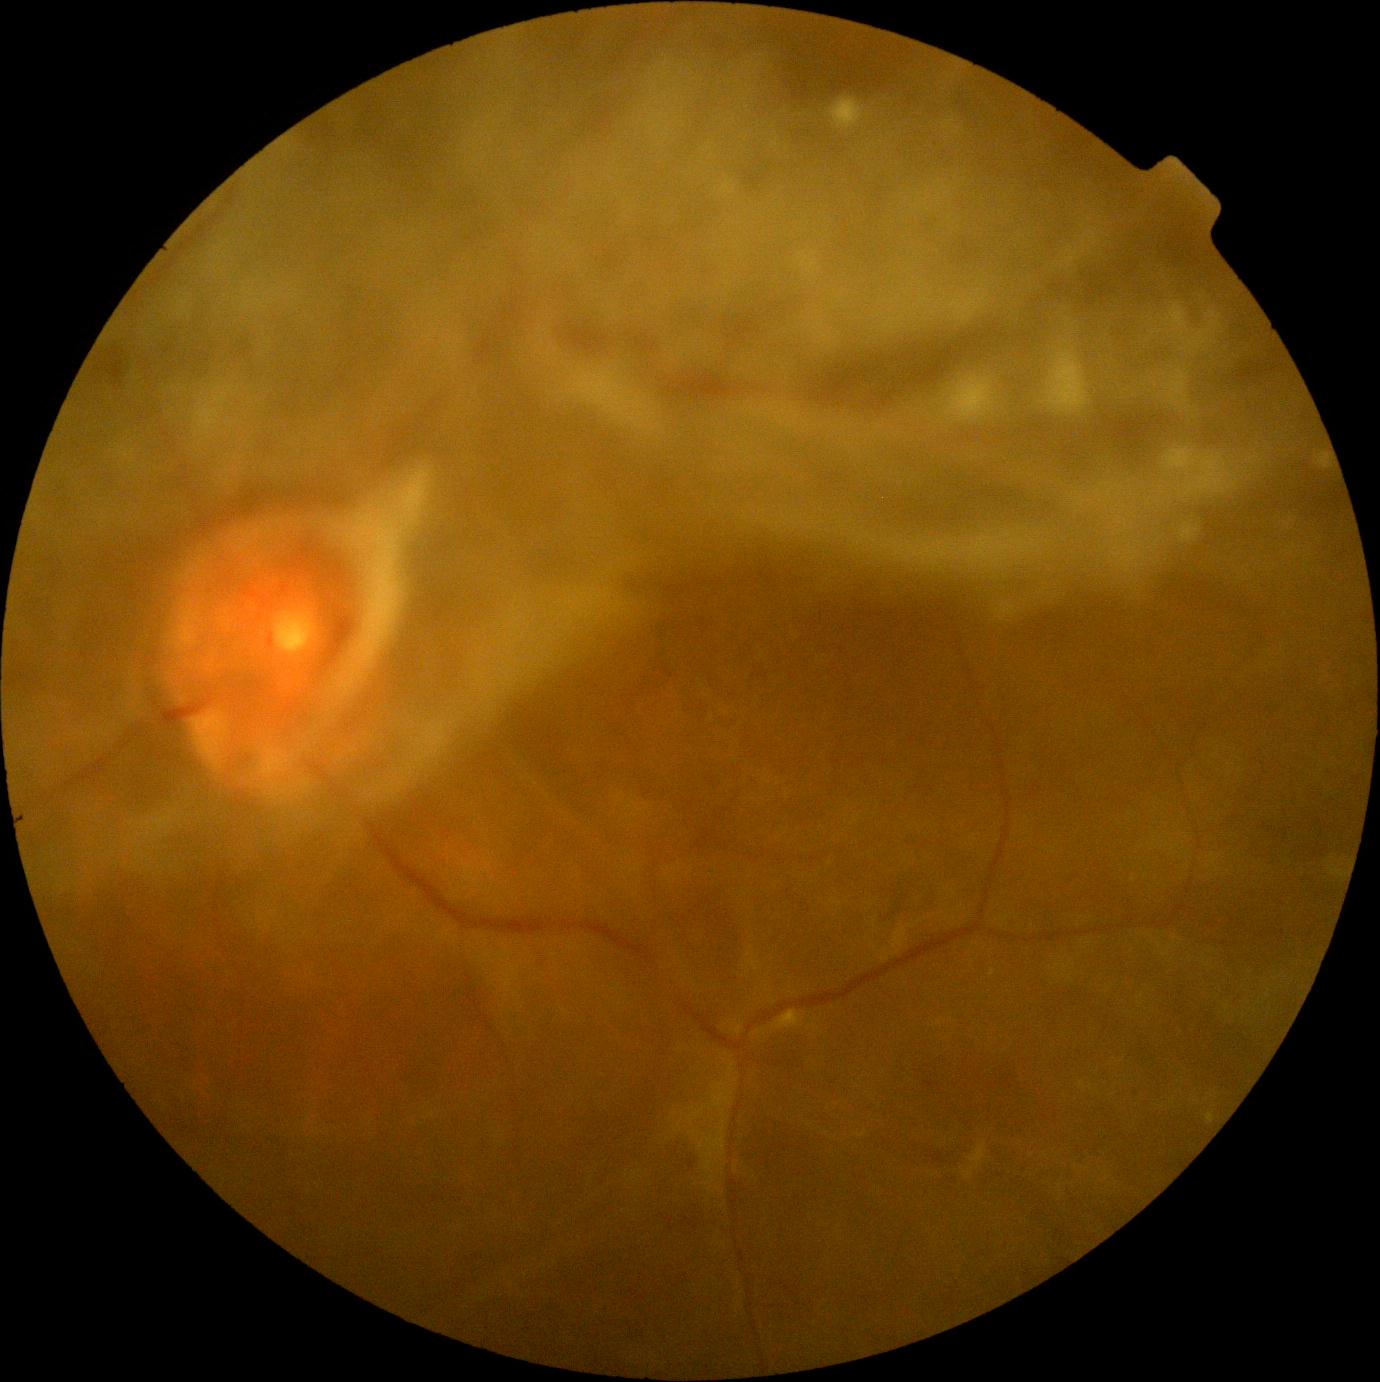

dr_grade: grade 4 (PDR)